Central corneal thickness: 500 µm; patient age: 54 years; intraocular pressure (pneumatic tonometry): 17 mmHg; refraction: +0.25 -0.25 x 160; female patient
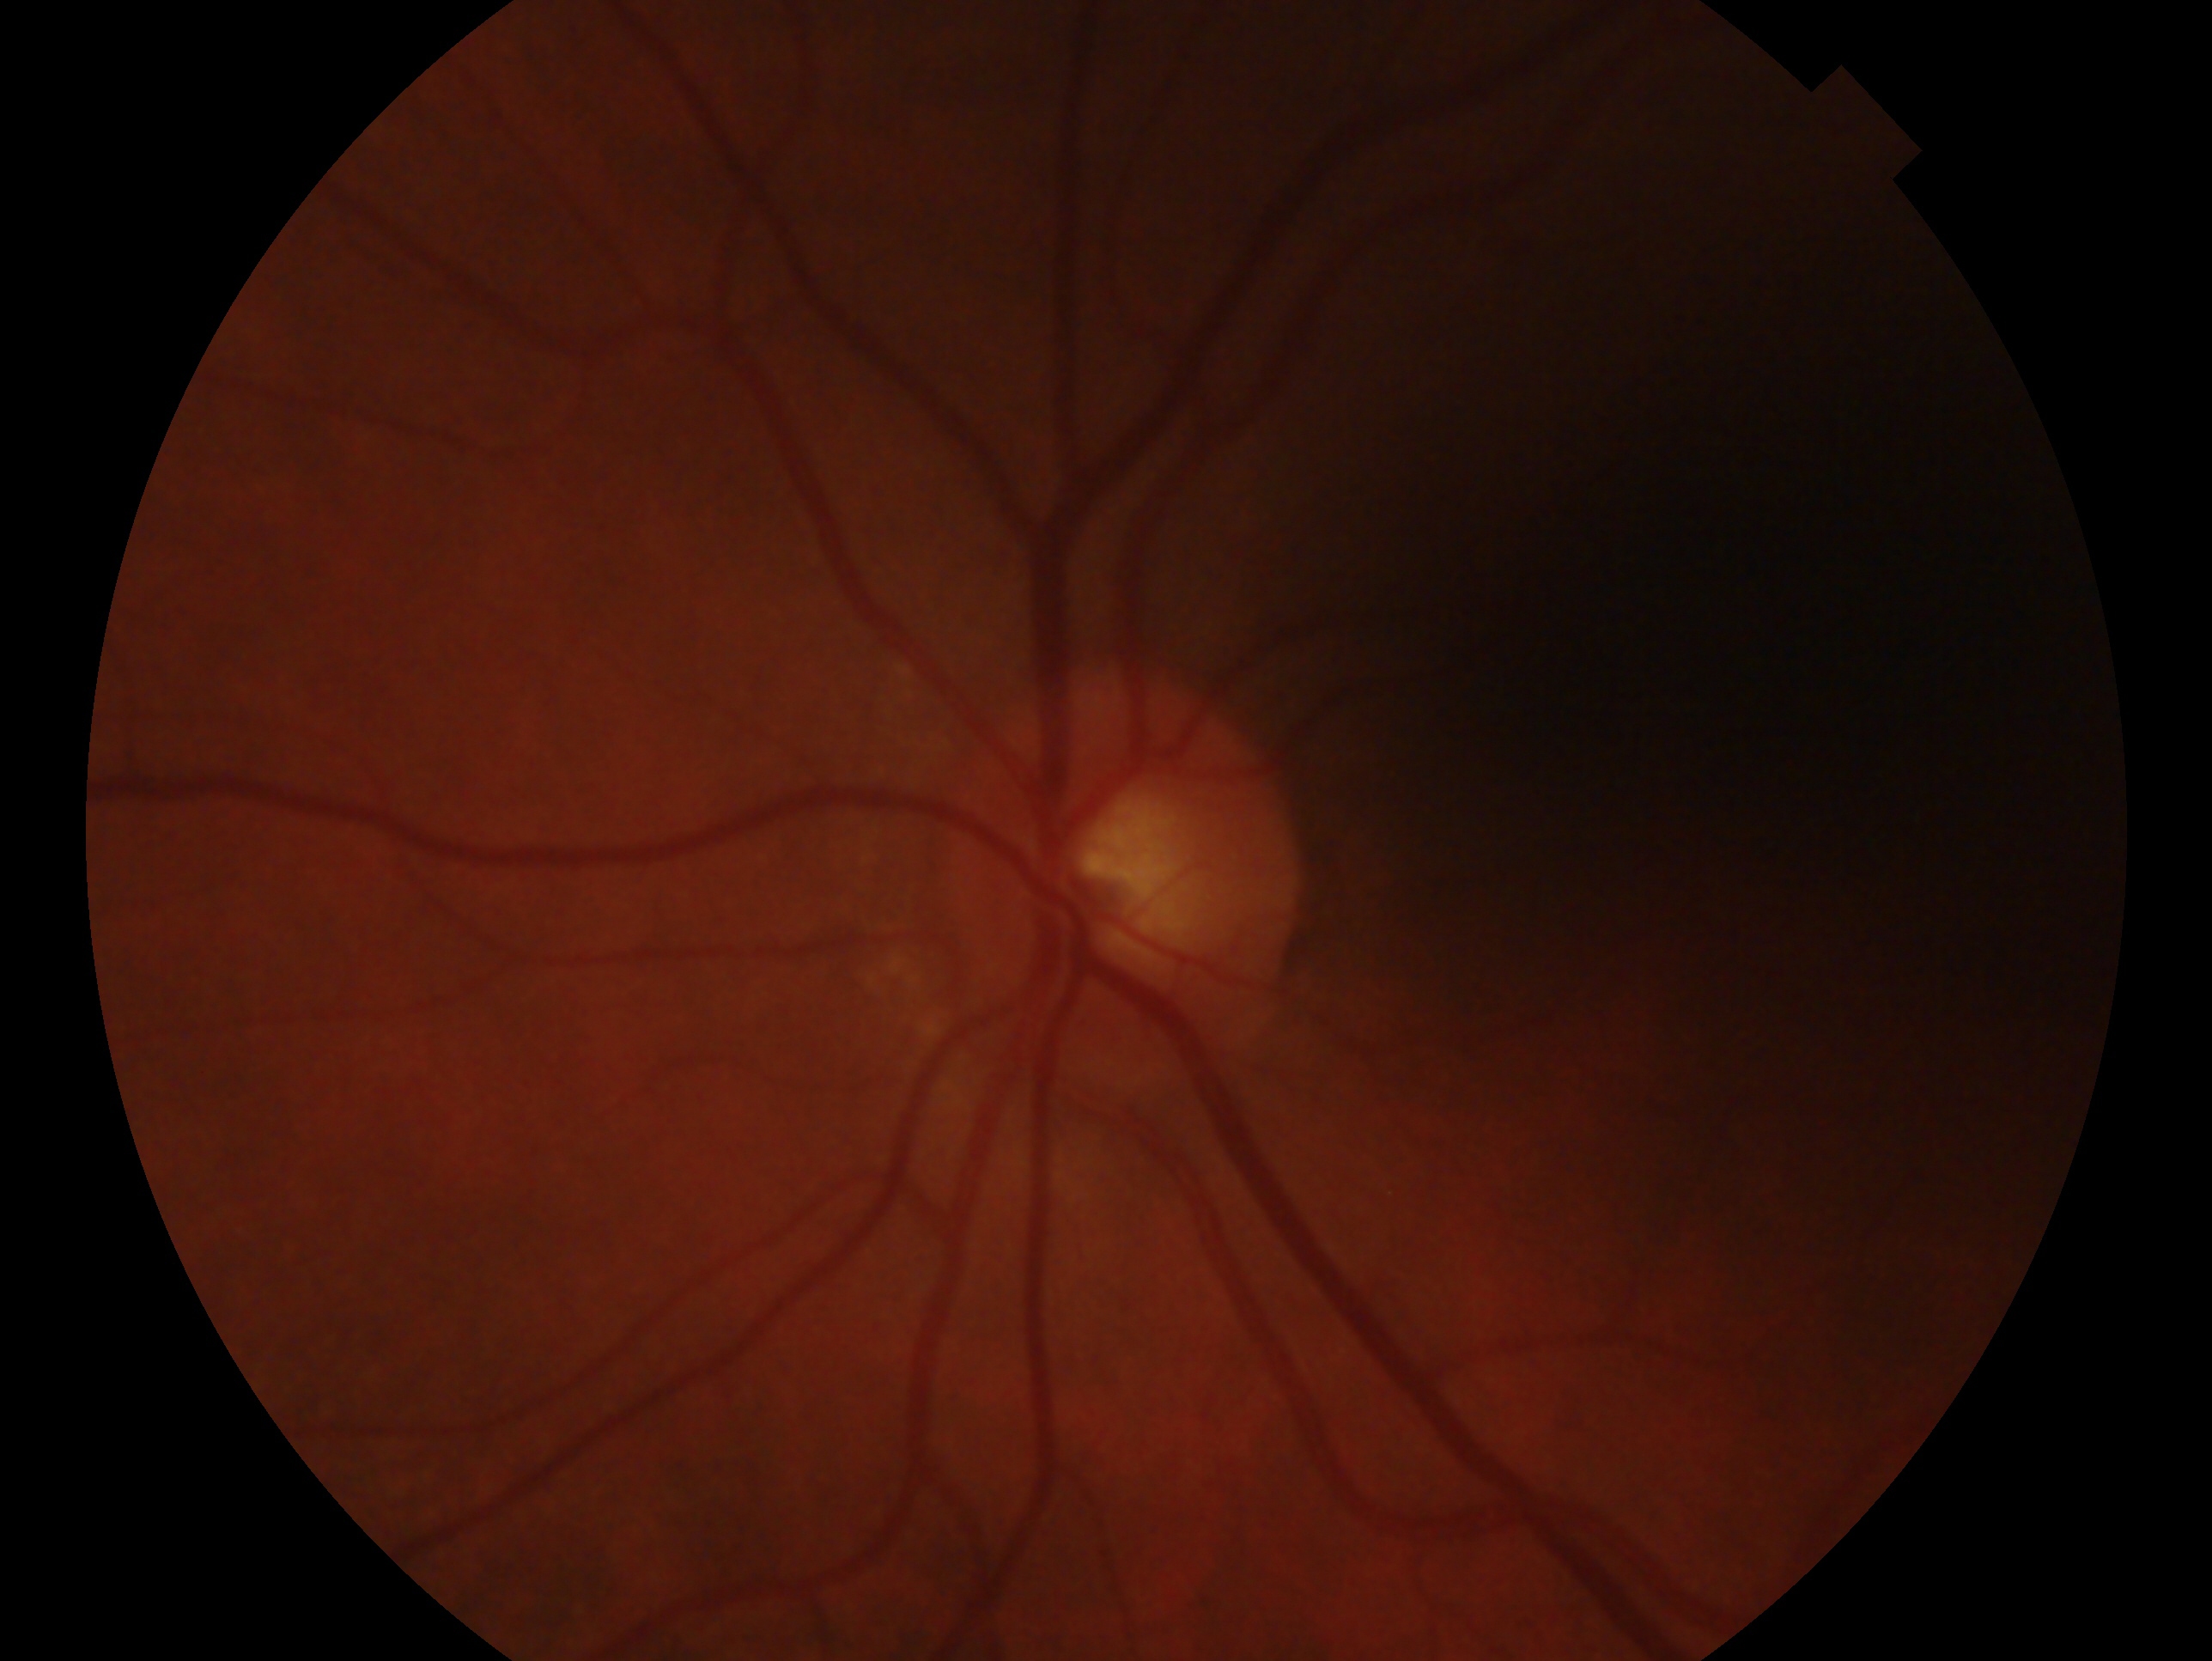
Eye: OS. Impression — no signs of glaucoma.